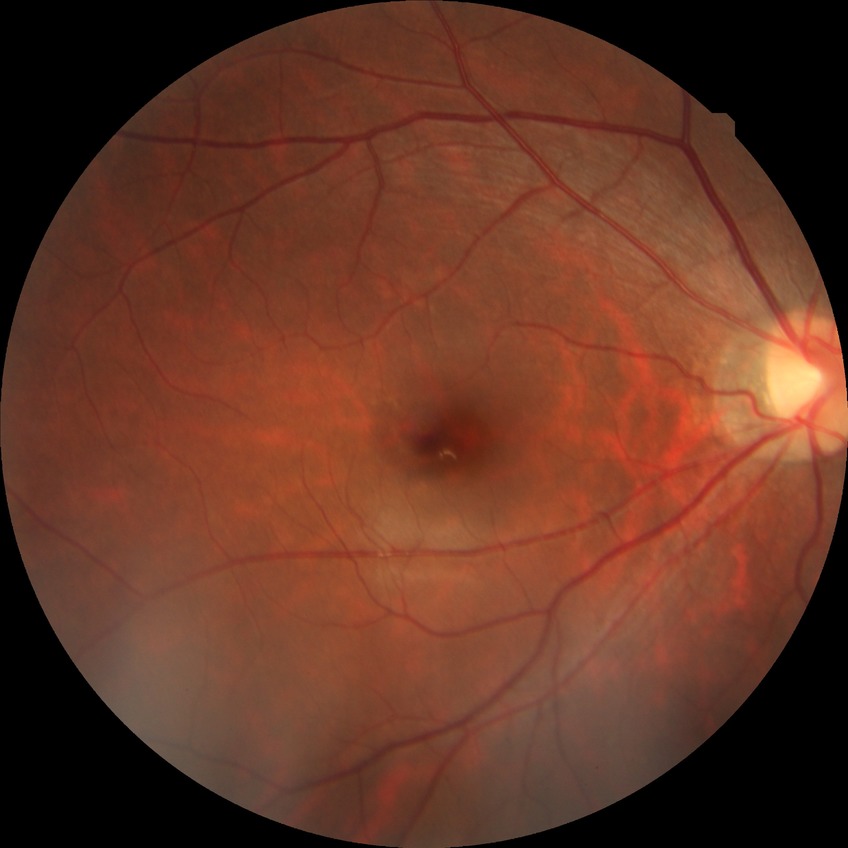

Modified Davis grading: no diabetic retinopathy.